45° FOV, image size 848x848, retinal fundus photograph, diabetic retinopathy graded by the modified Davis classification, camera: NIDEK AFC-230:
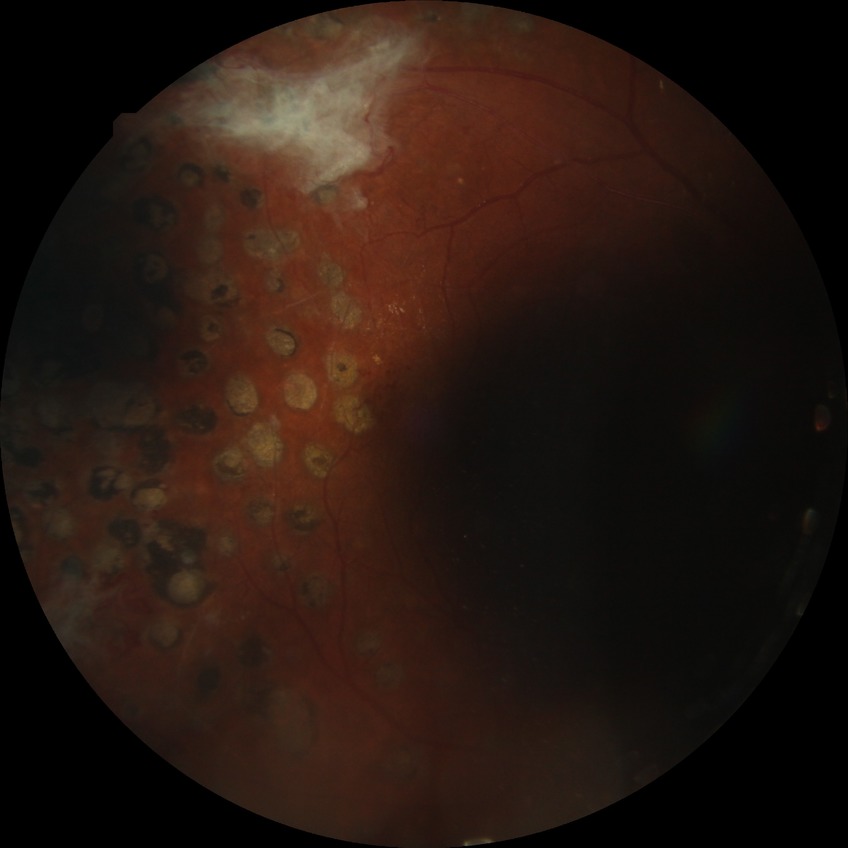 Diabetic retinopathy (DR): proliferative diabetic retinopathy (PDR).